45° field of view · NIDEK AFC-230:
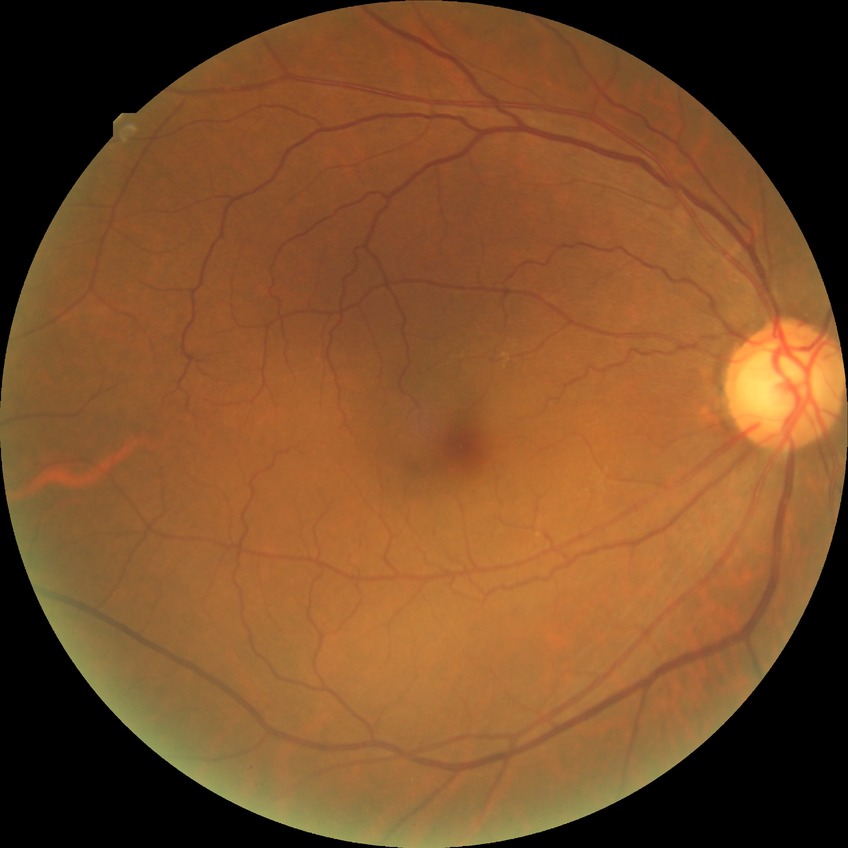

Diabetic retinopathy stage: no diabetic retinopathy.